NIDEK AFC-230
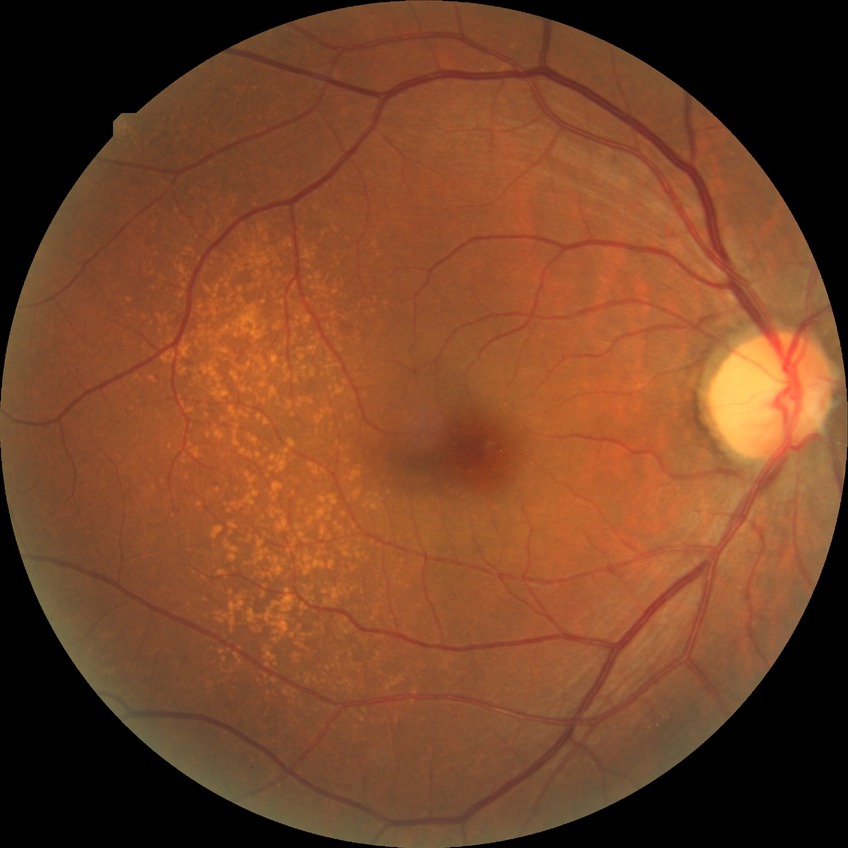
Diabetic retinopathy (DR): no diabetic retinopathy (NDR).